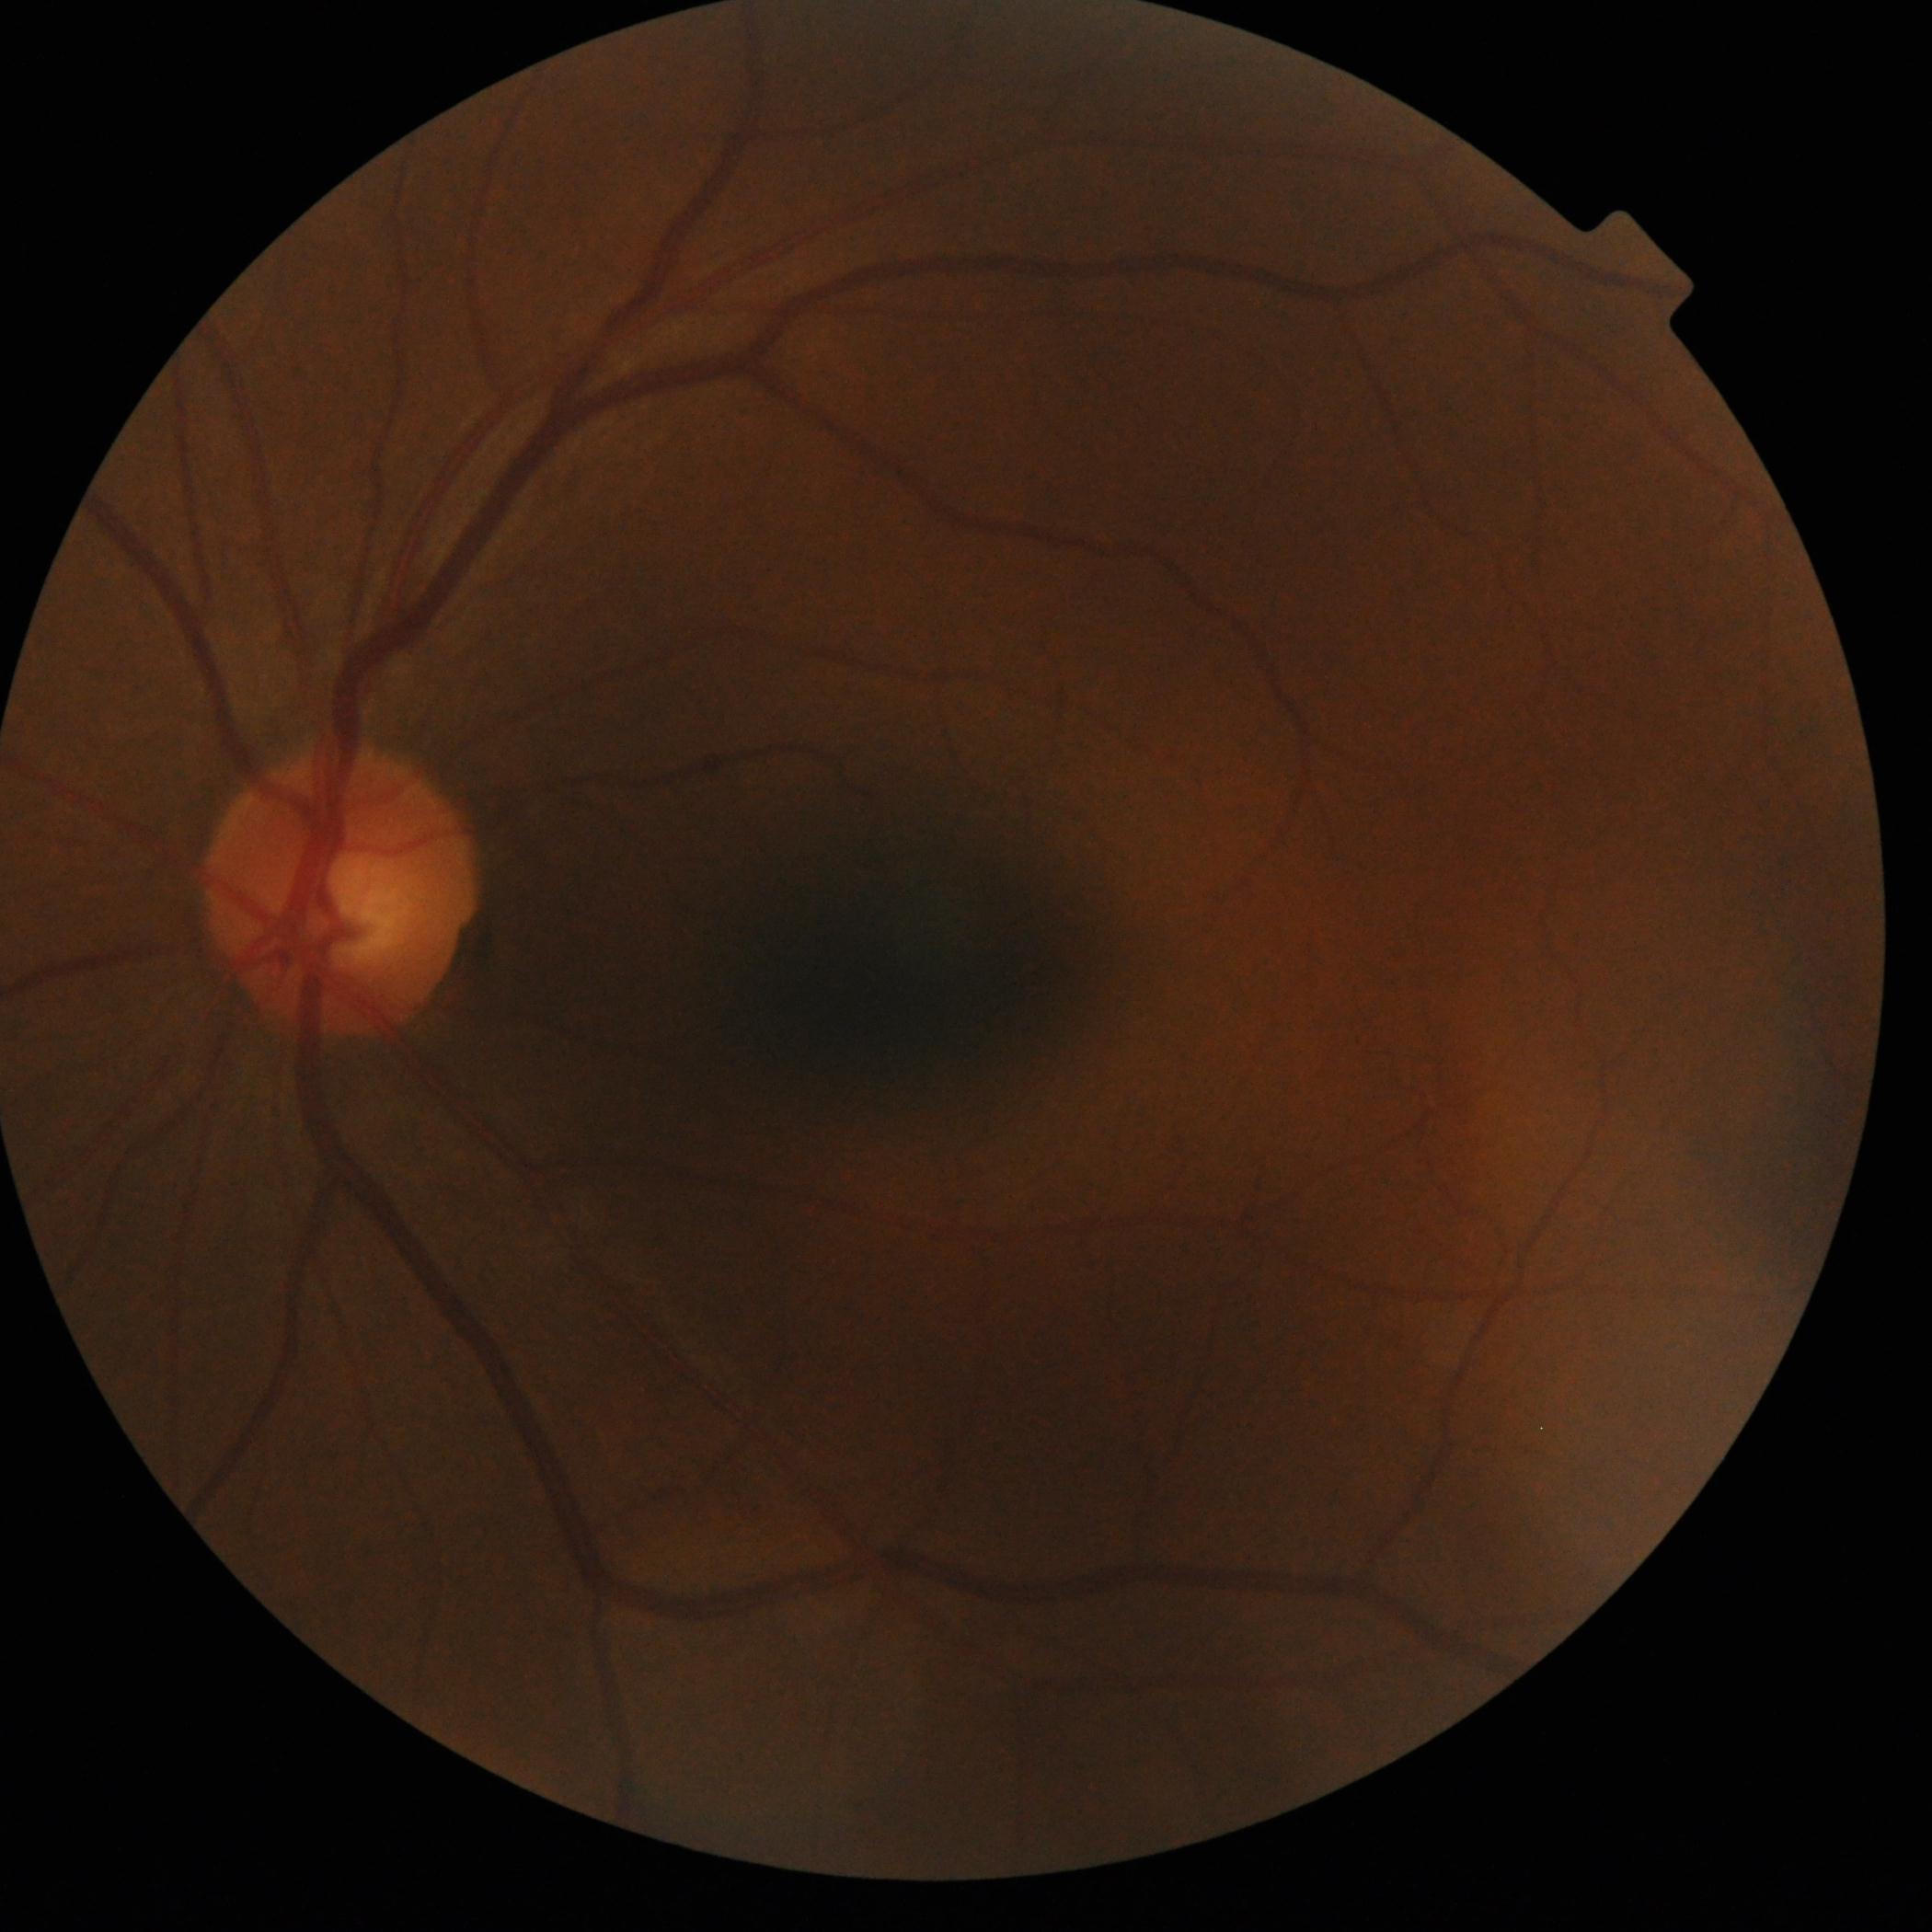

diabetic retinopathy (DR)=grade 0; DR impression=no apparent DR.